Posterior pole photograph · NIDEK AFC-230 fundus camera · image size 848x848 — 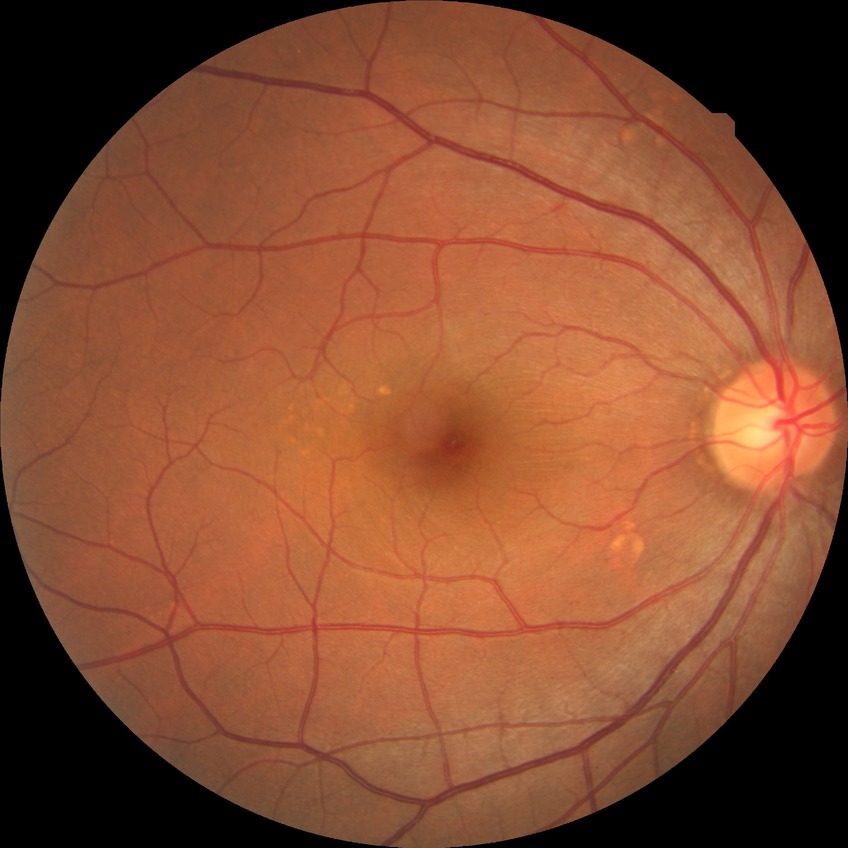 Annotations:
- diabetic retinopathy (DR) — no diabetic retinopathy (NDR)